Fundus photo — 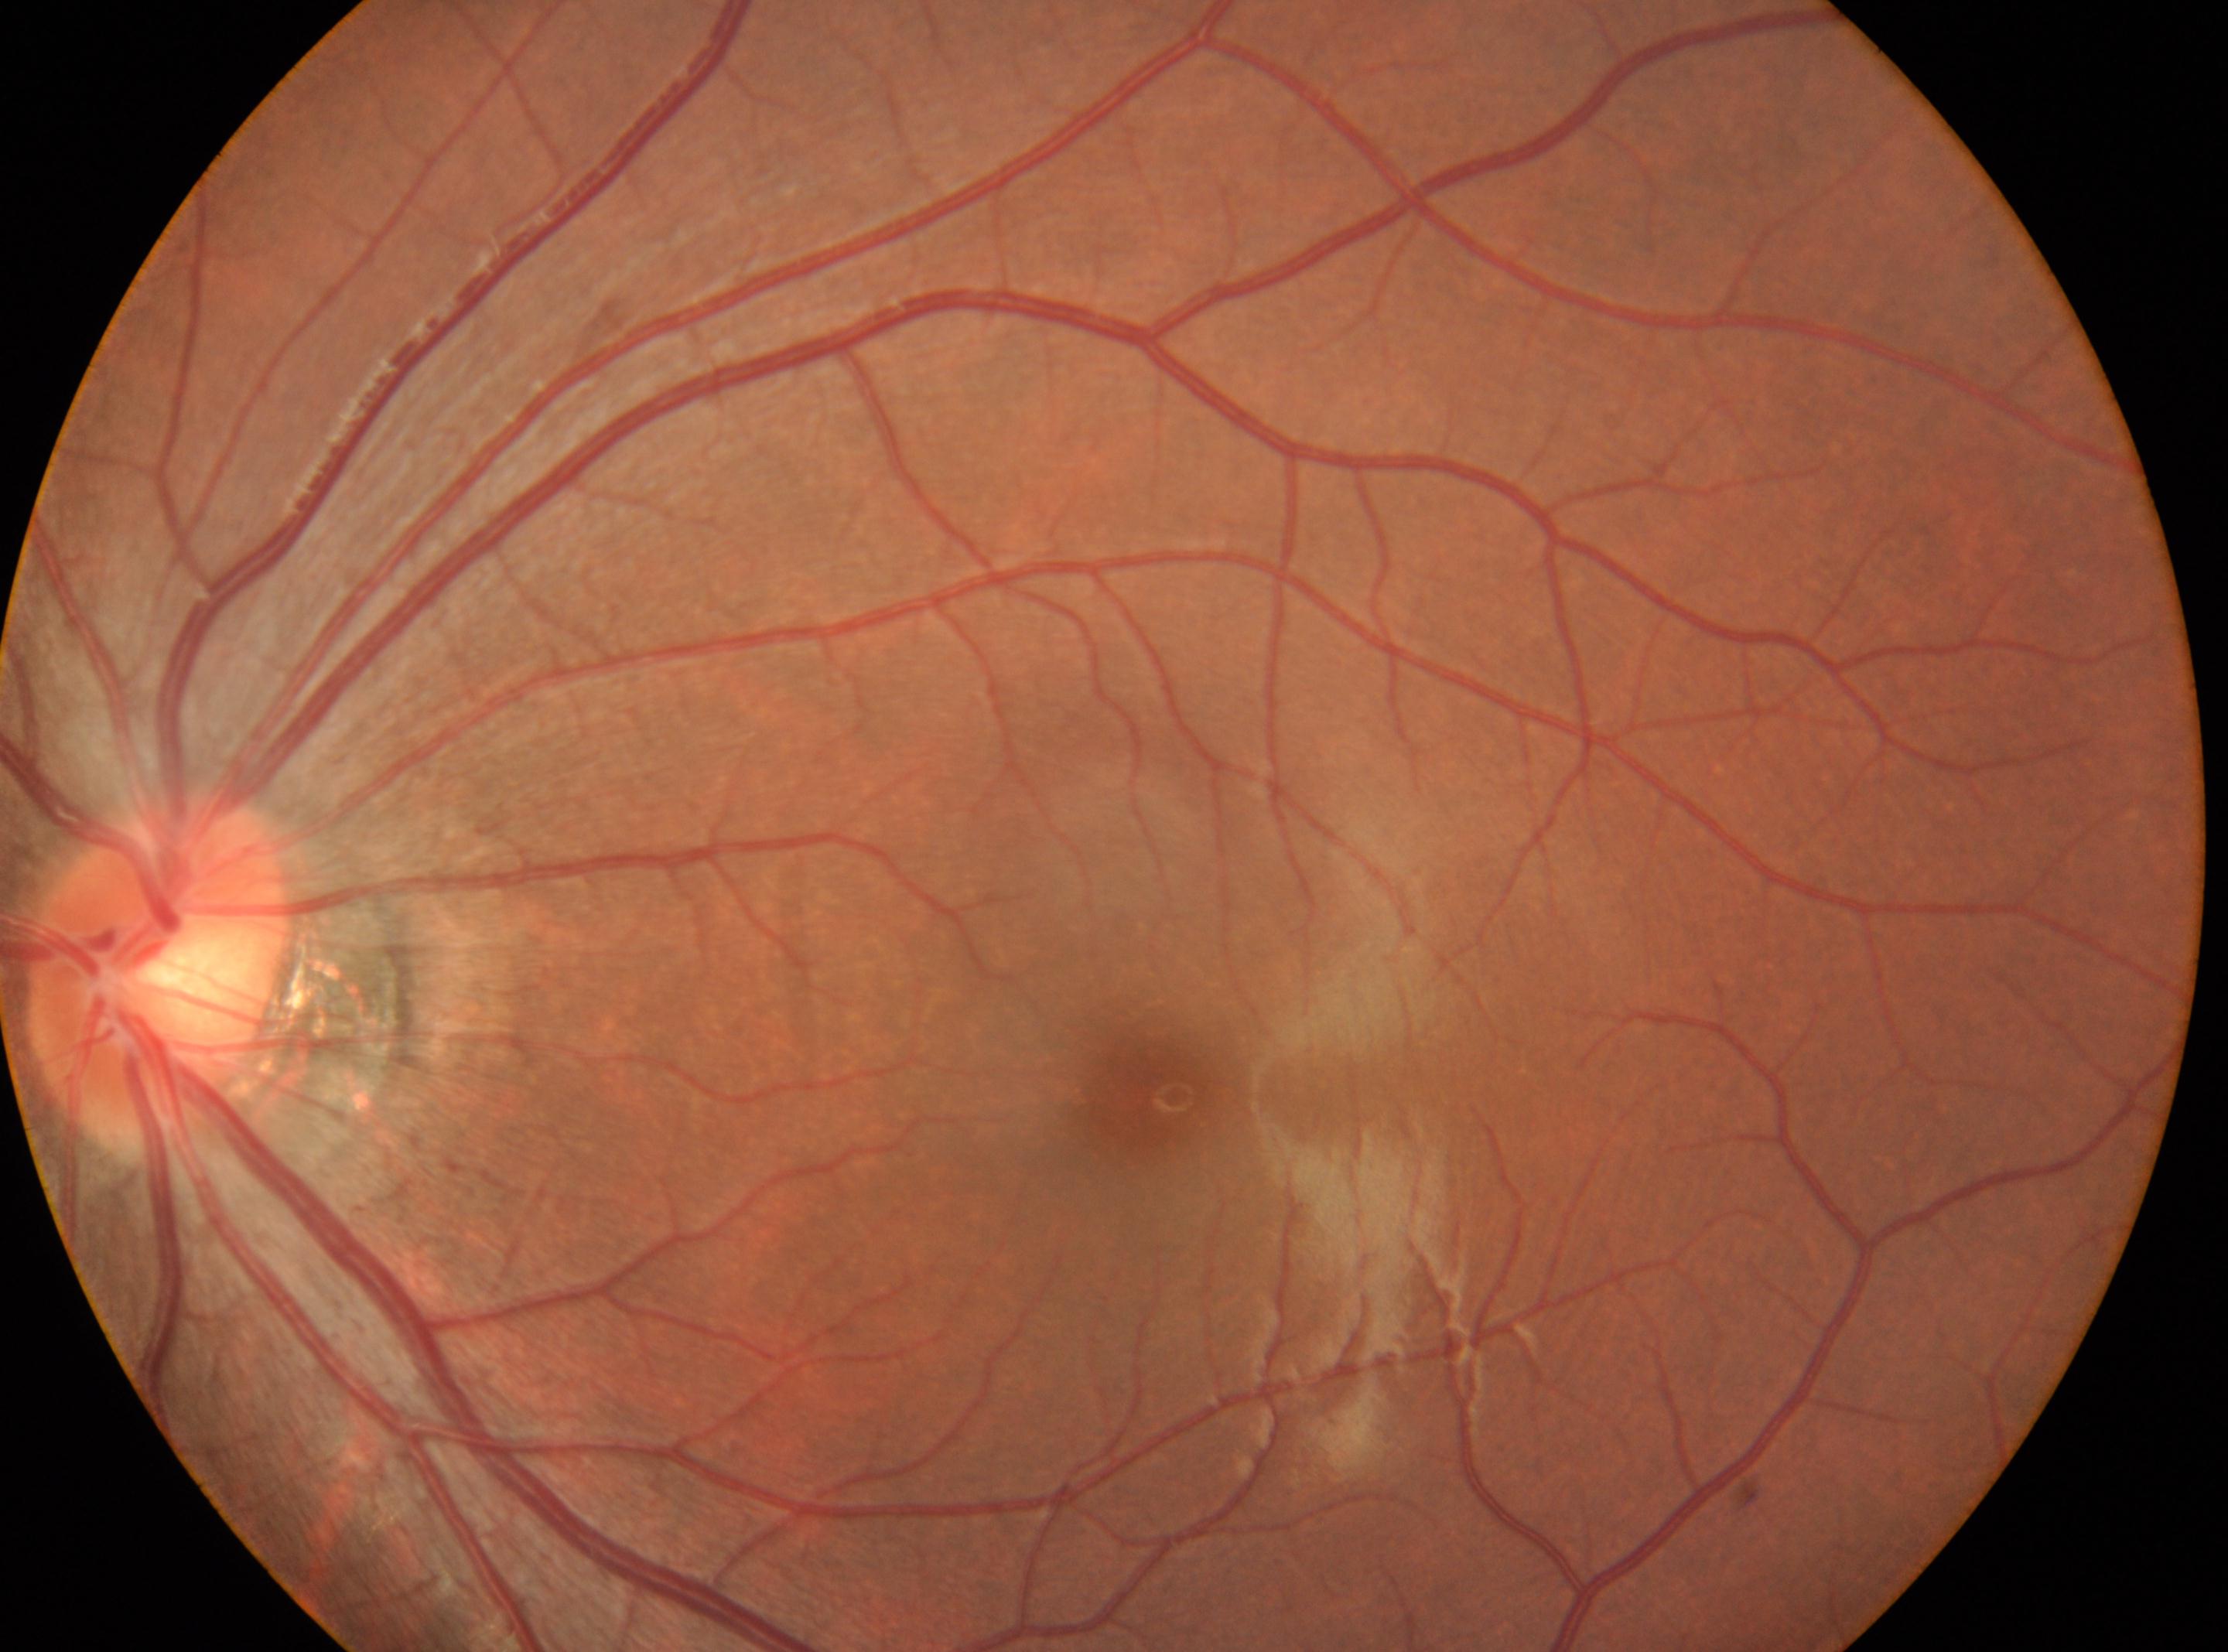
| key | value |
|---|---|
| optic disk | [159, 976] |
| laterality | oculus sinister |
| DR grade | 0 (no apparent retinopathy) |
| foveal center | [1162, 1097] |